CFP.
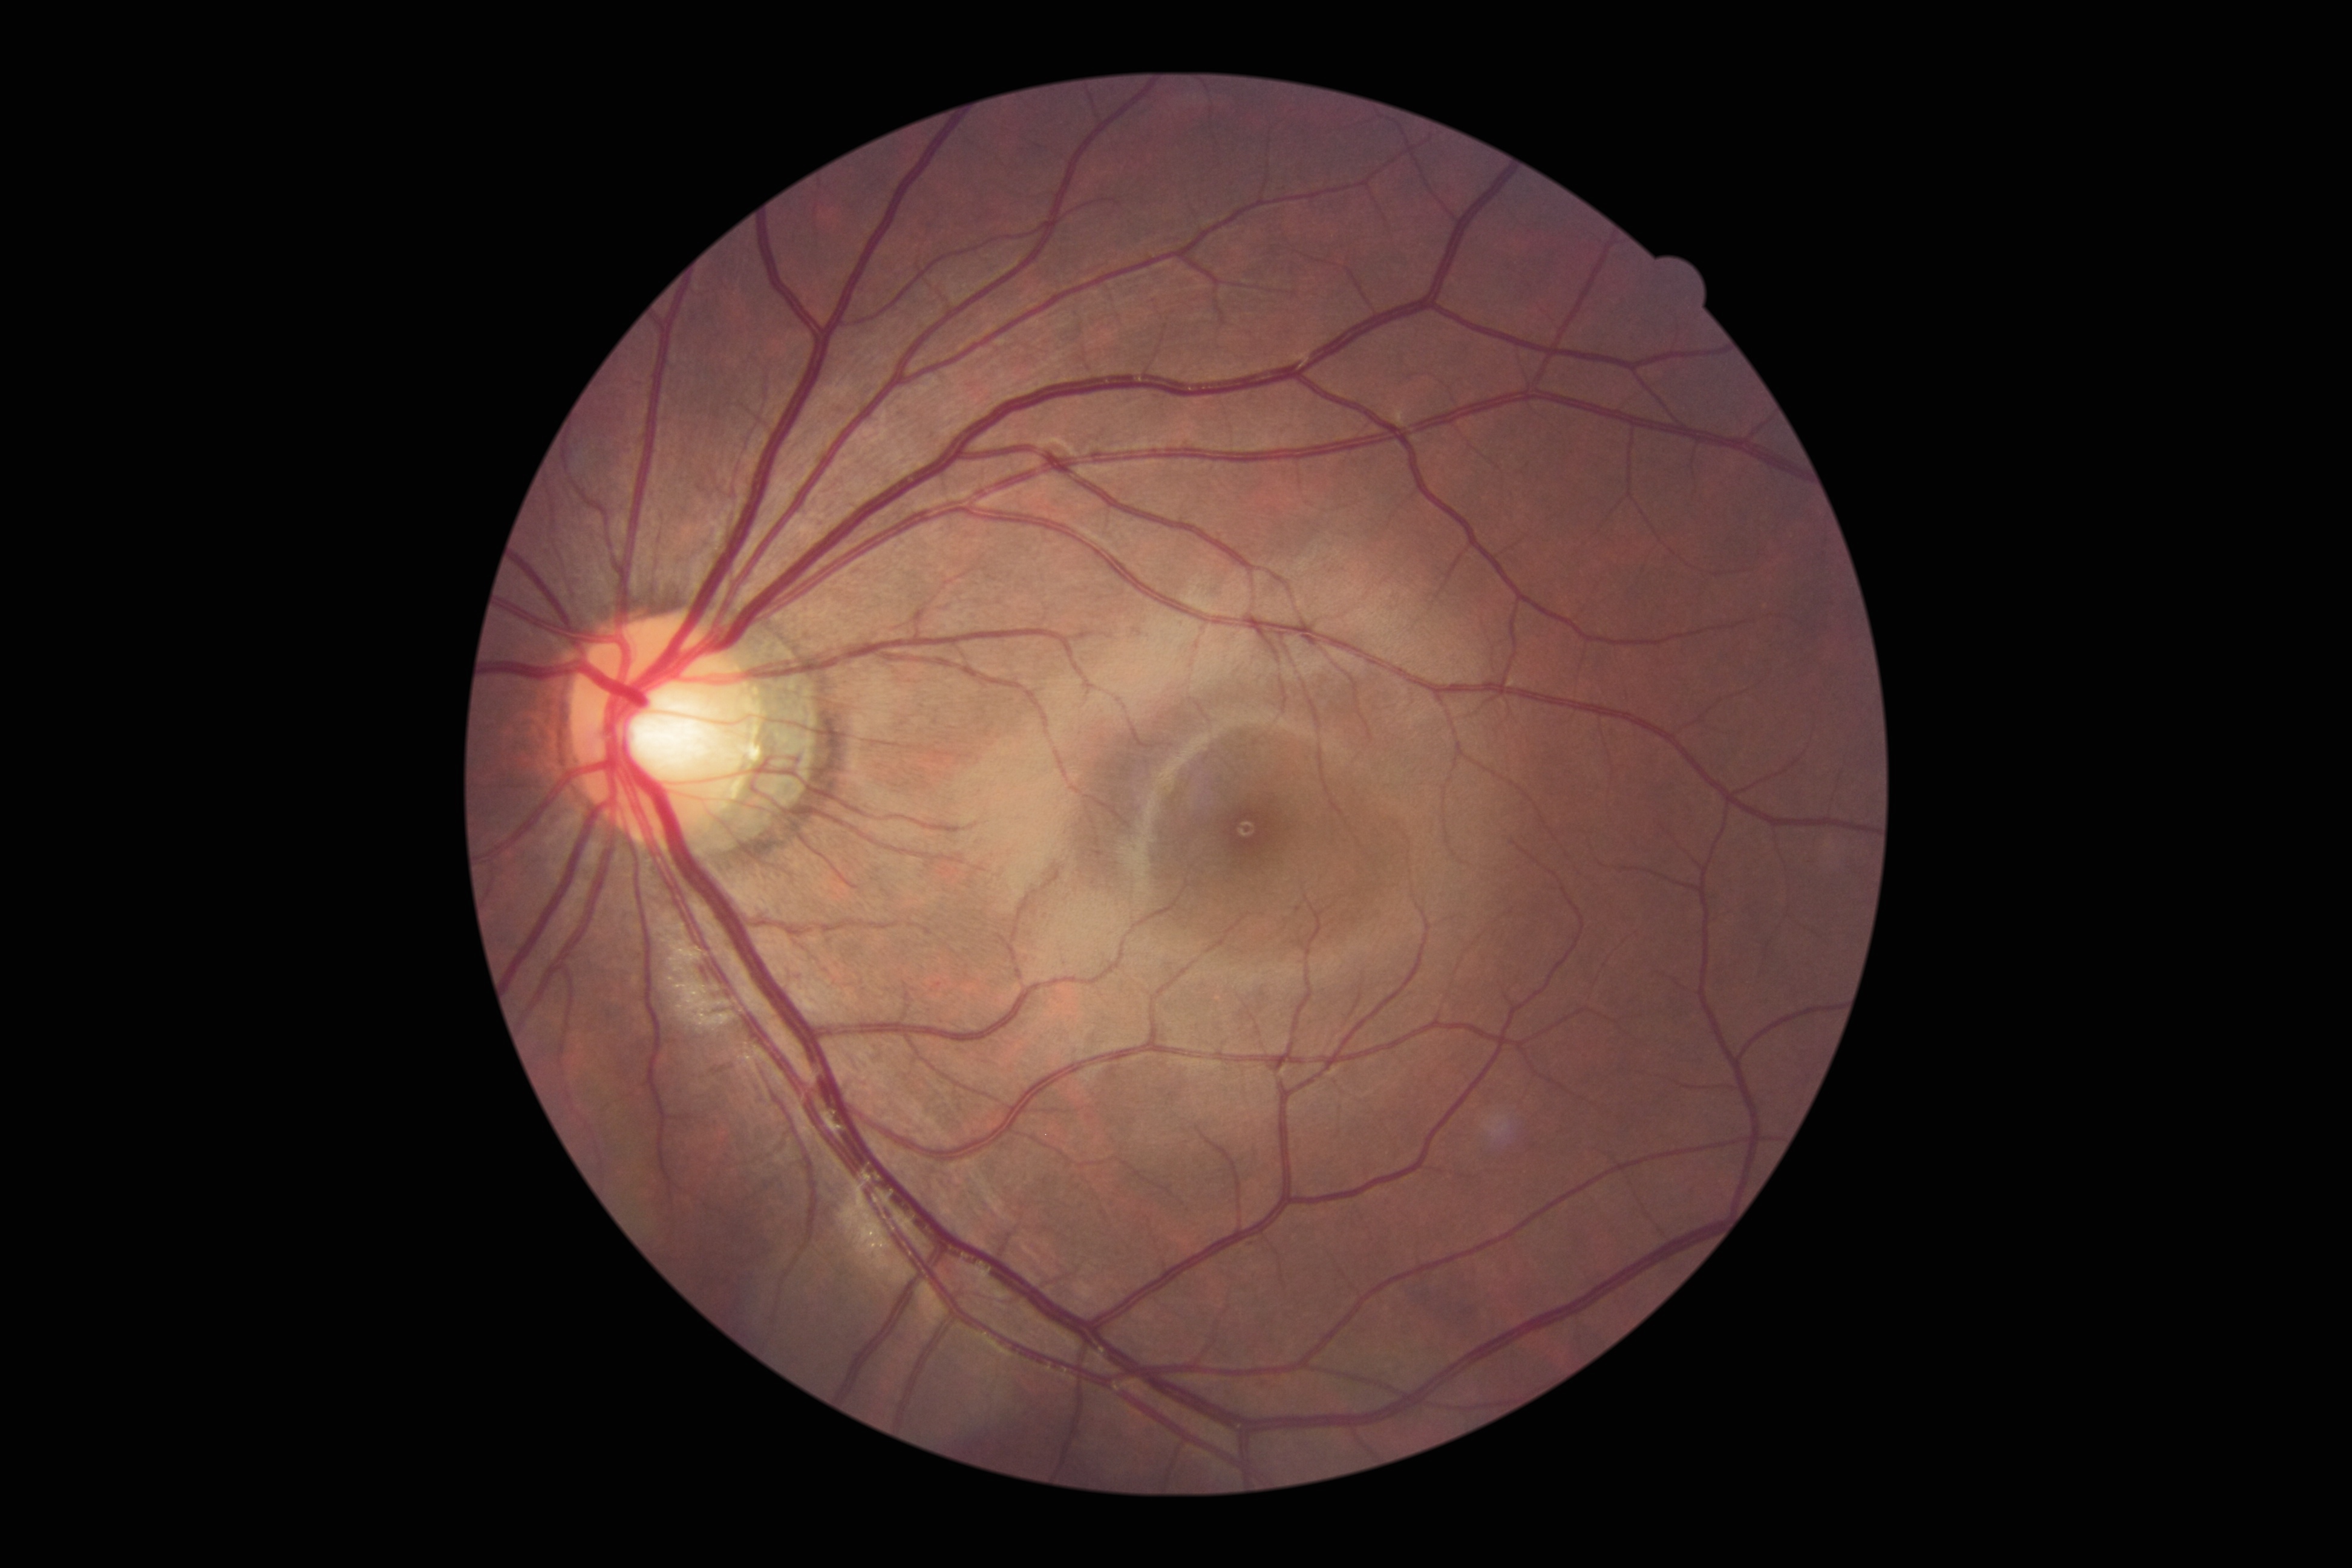 - DR grade: 0
- DR impression: no apparent DR